Retinal fundus photograph: 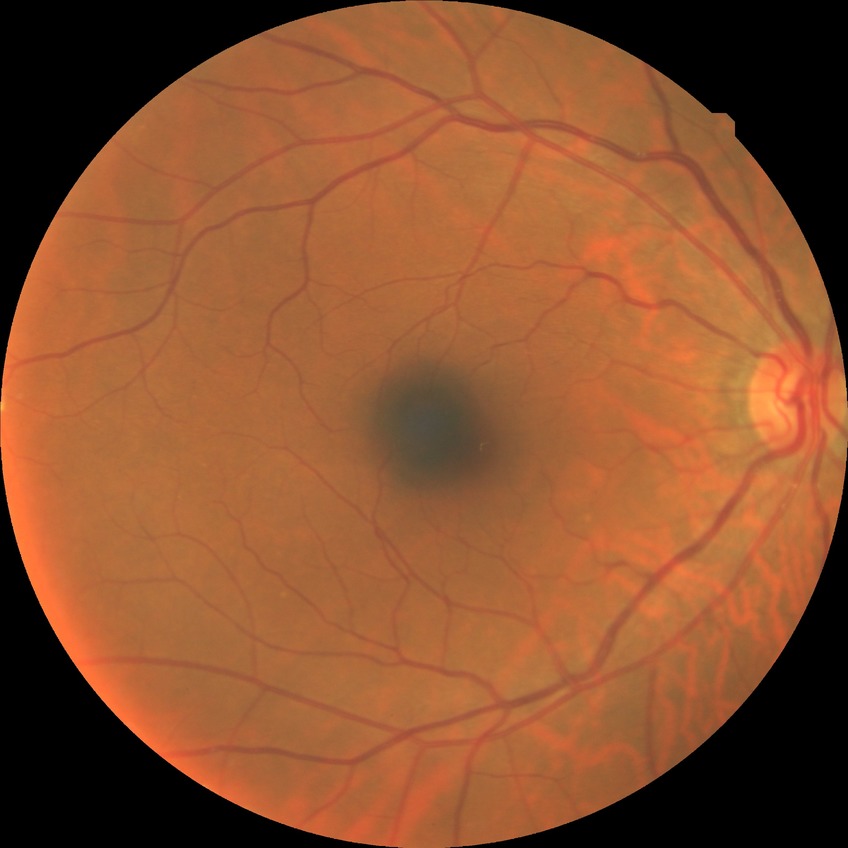
Diabetic retinopathy (DR) is NDR (no diabetic retinopathy).